Color fundus photograph, without pupil dilation, image size 848x848, 45 degree fundus photograph: 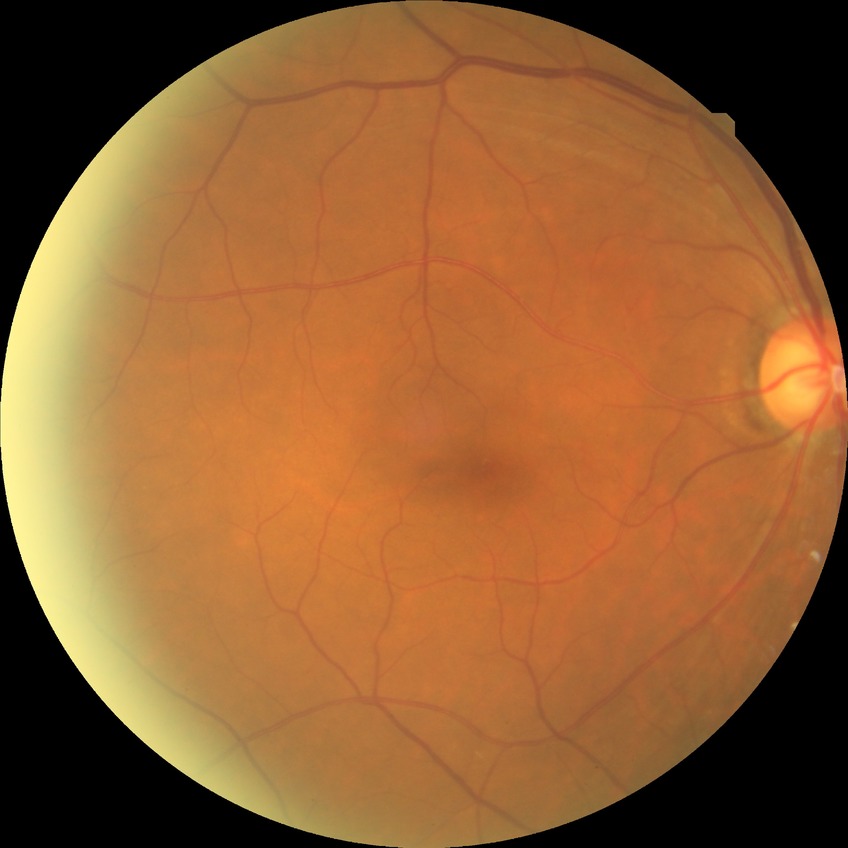 Retinopathy stage: no diabetic retinopathy.